Handheld portable fundus camera image.
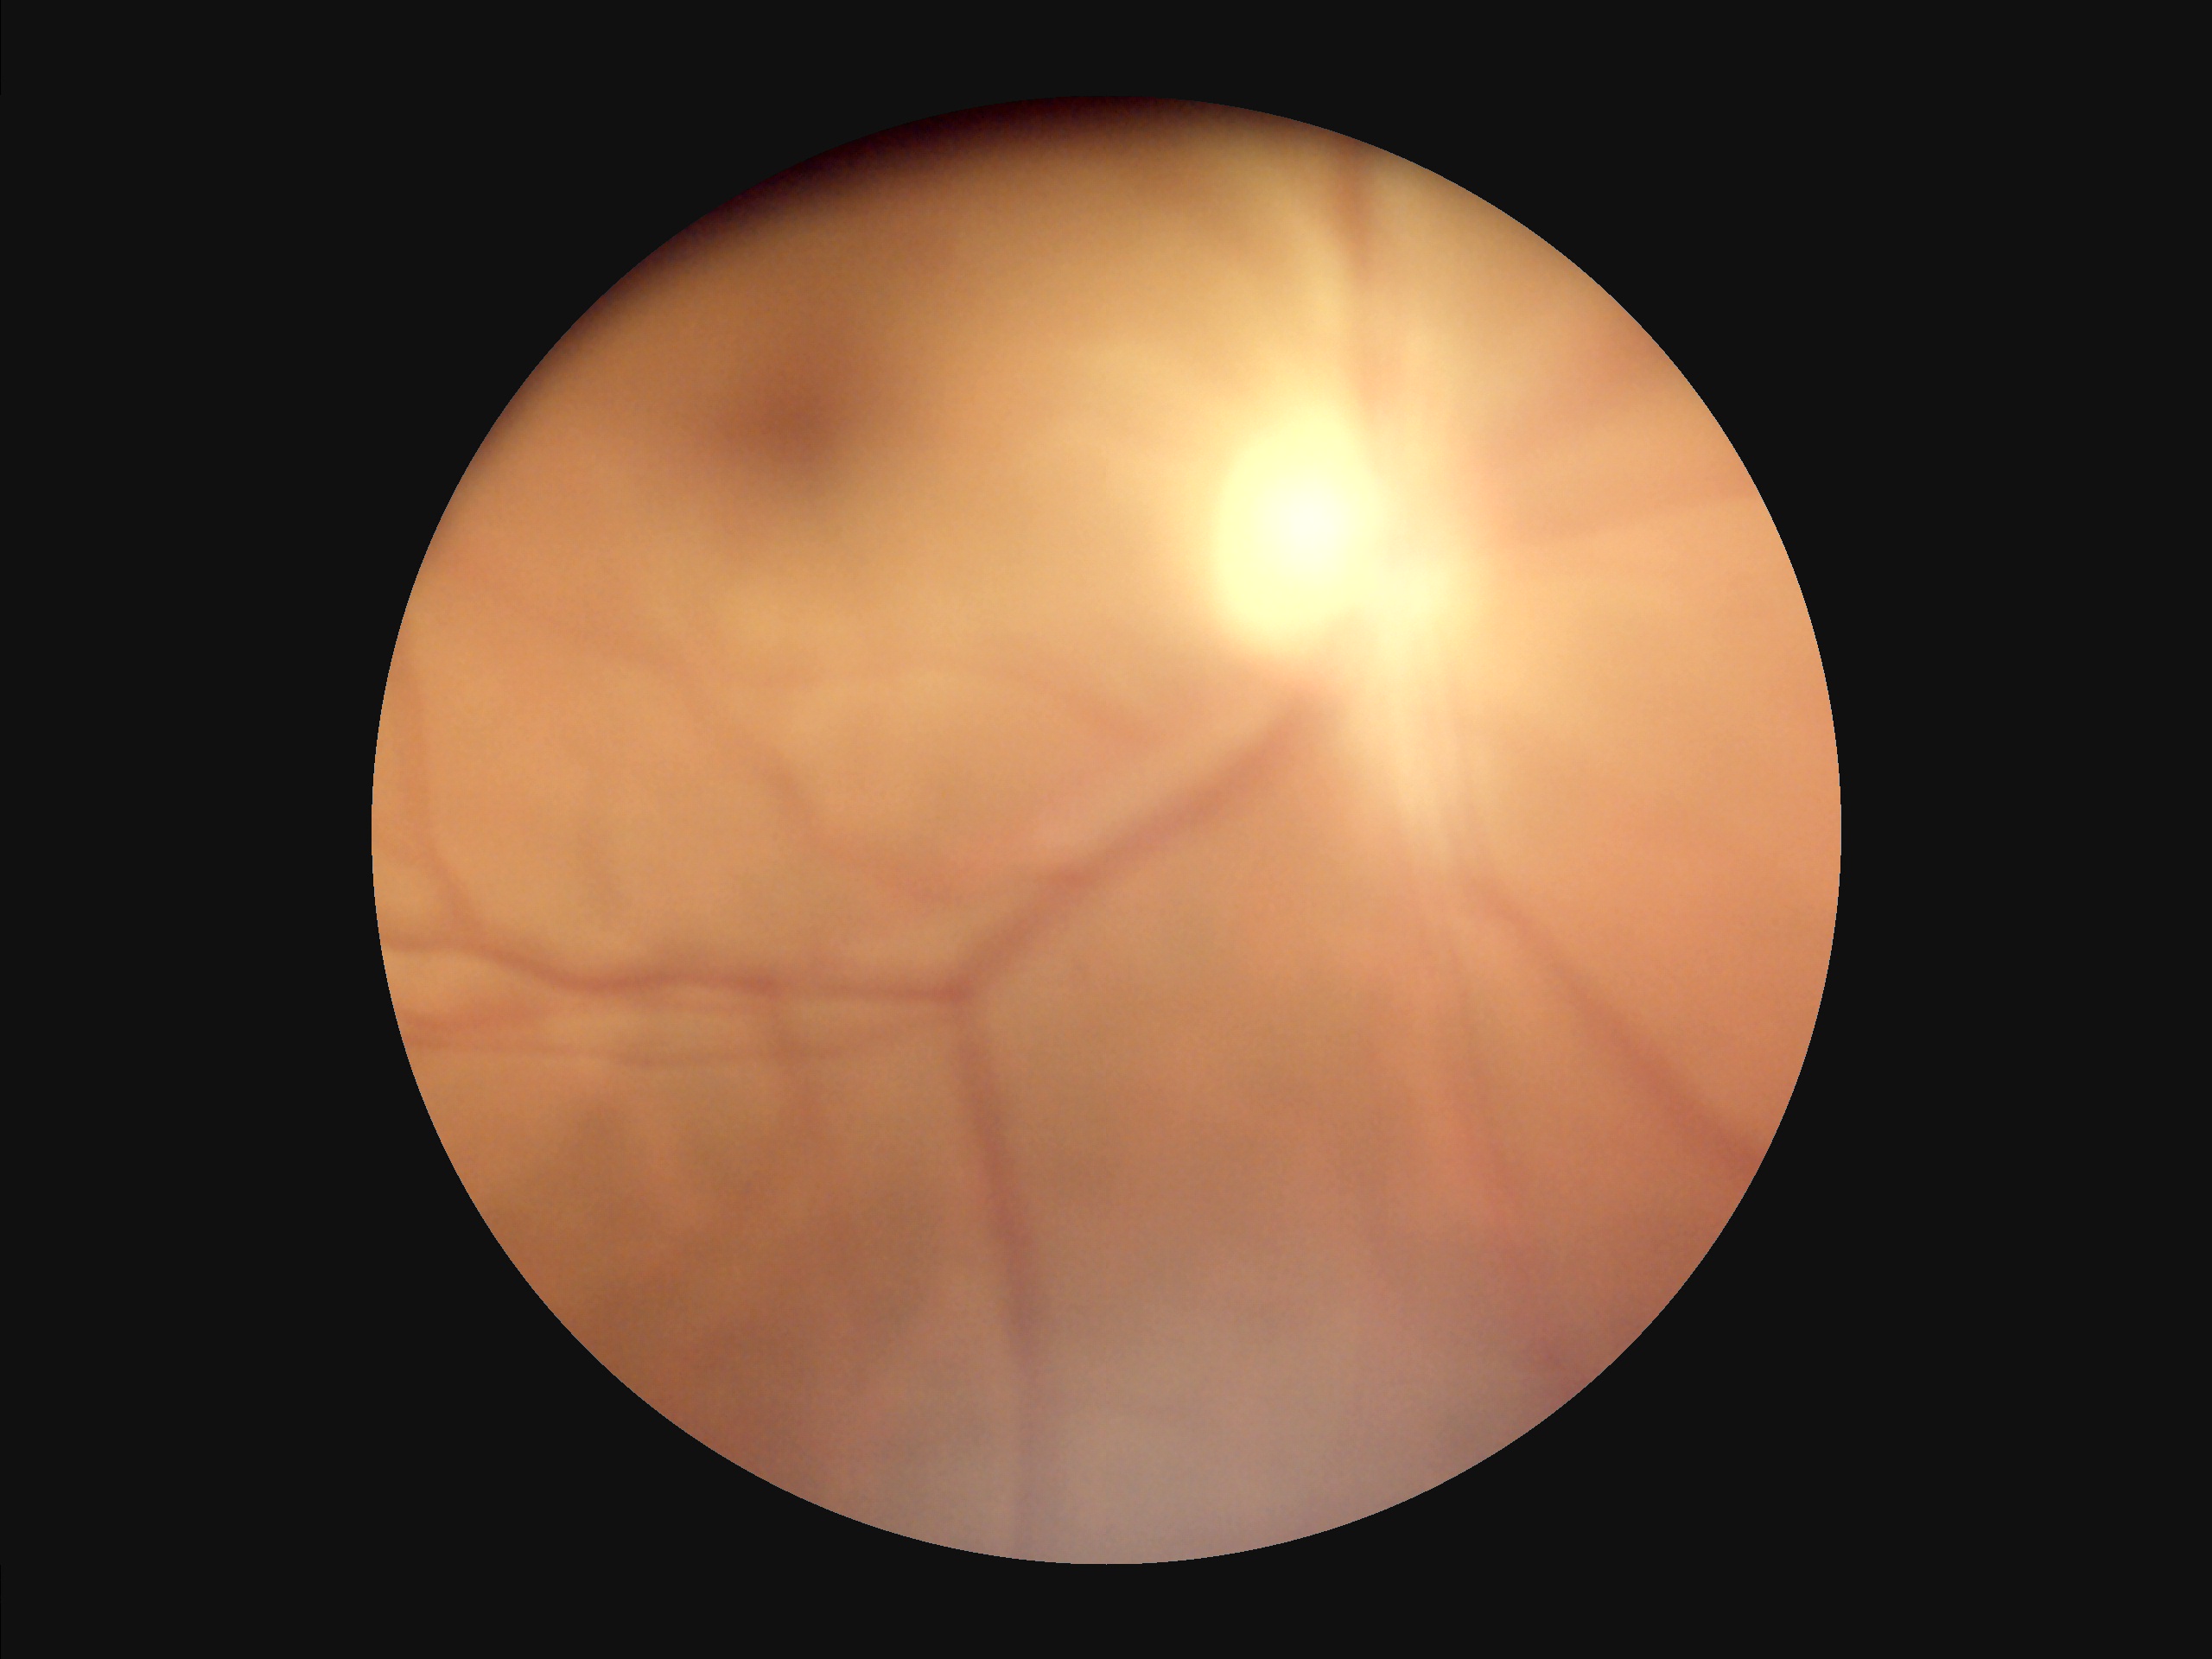

{
  "illumination": "even and well-balanced",
  "overall_quality": "poor, ungradable",
  "clarity": "reduced sharpness with visible blur",
  "contrast": "vessels and details readily distinguishable"
}